CFP.
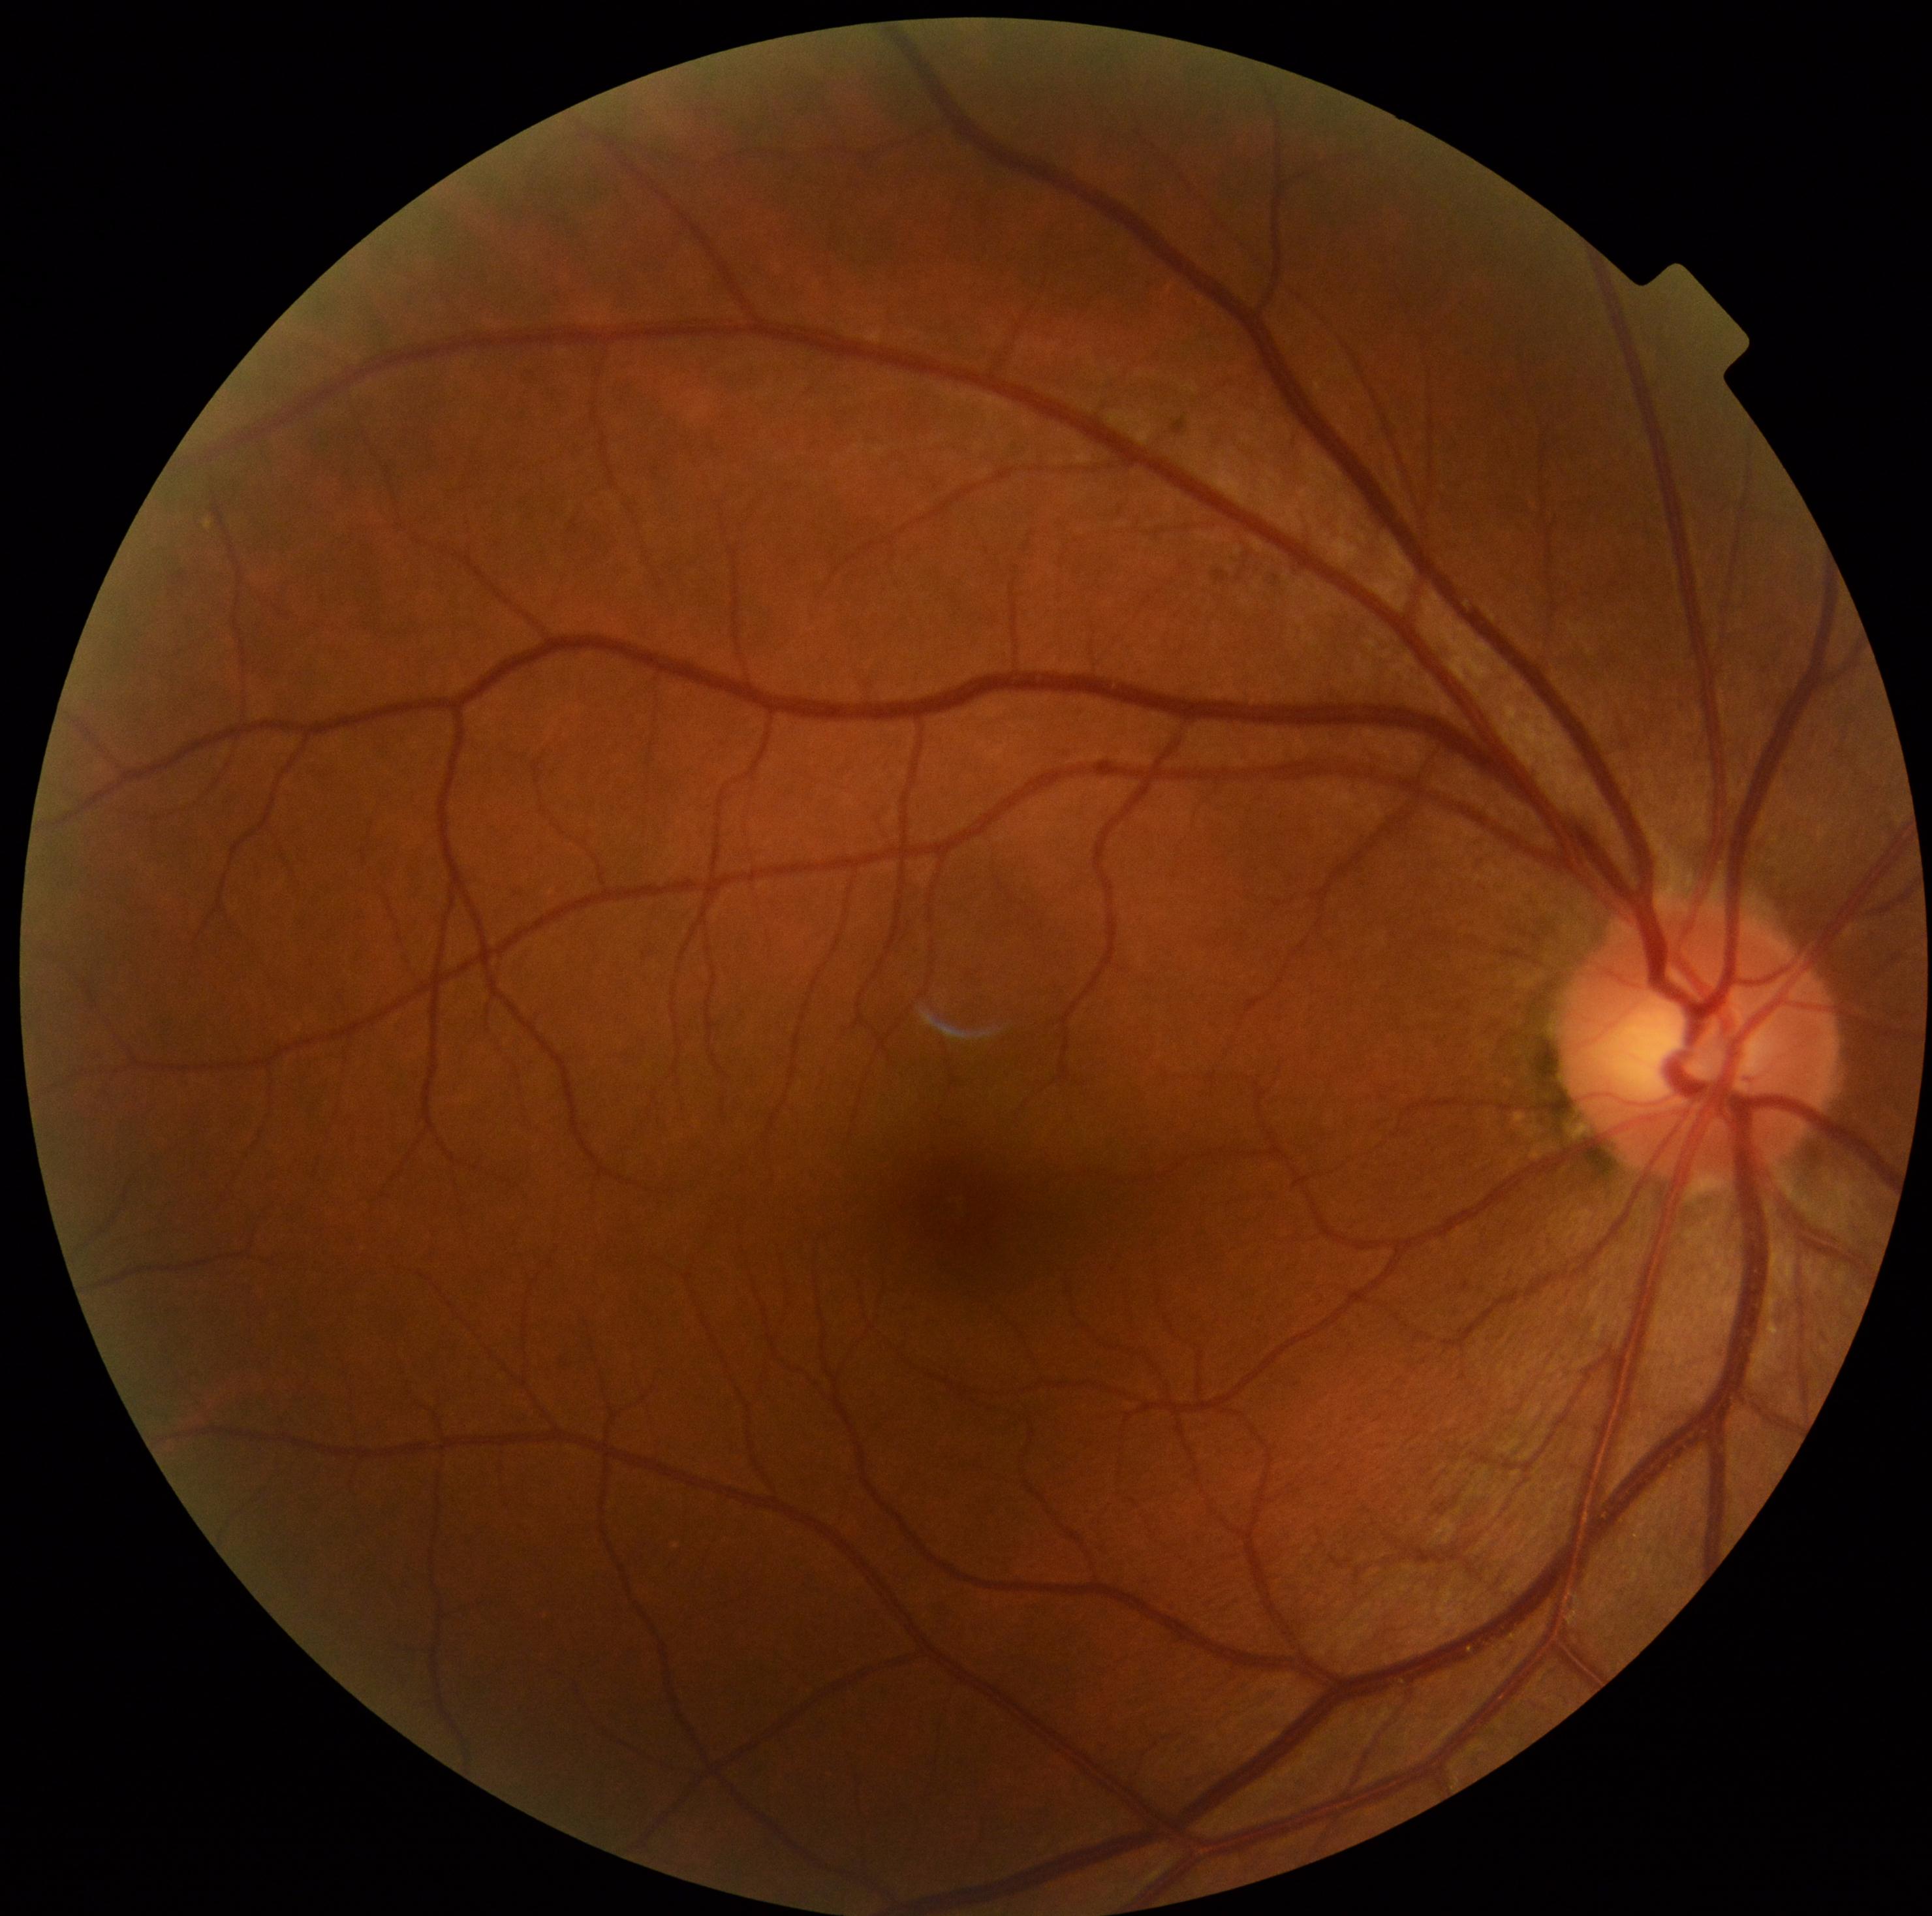 Annotations:
– diabetic retinopathy (DR) — no apparent retinopathy (grade 0)